FOV: 45 degrees
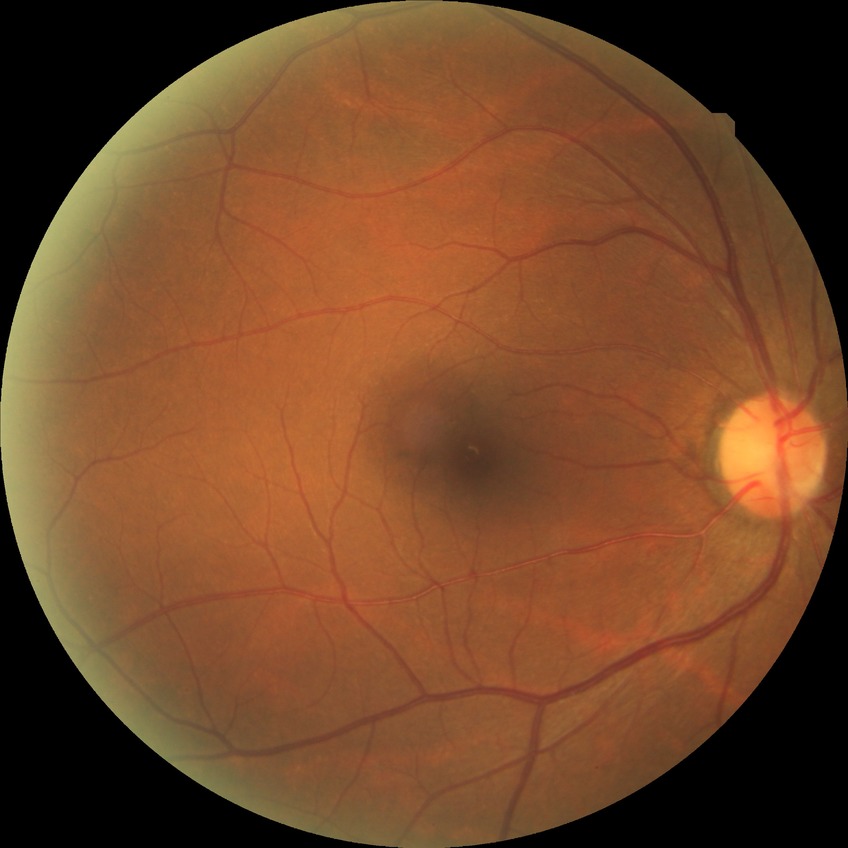

Diabetic retinopathy (DR): NDR (no diabetic retinopathy).